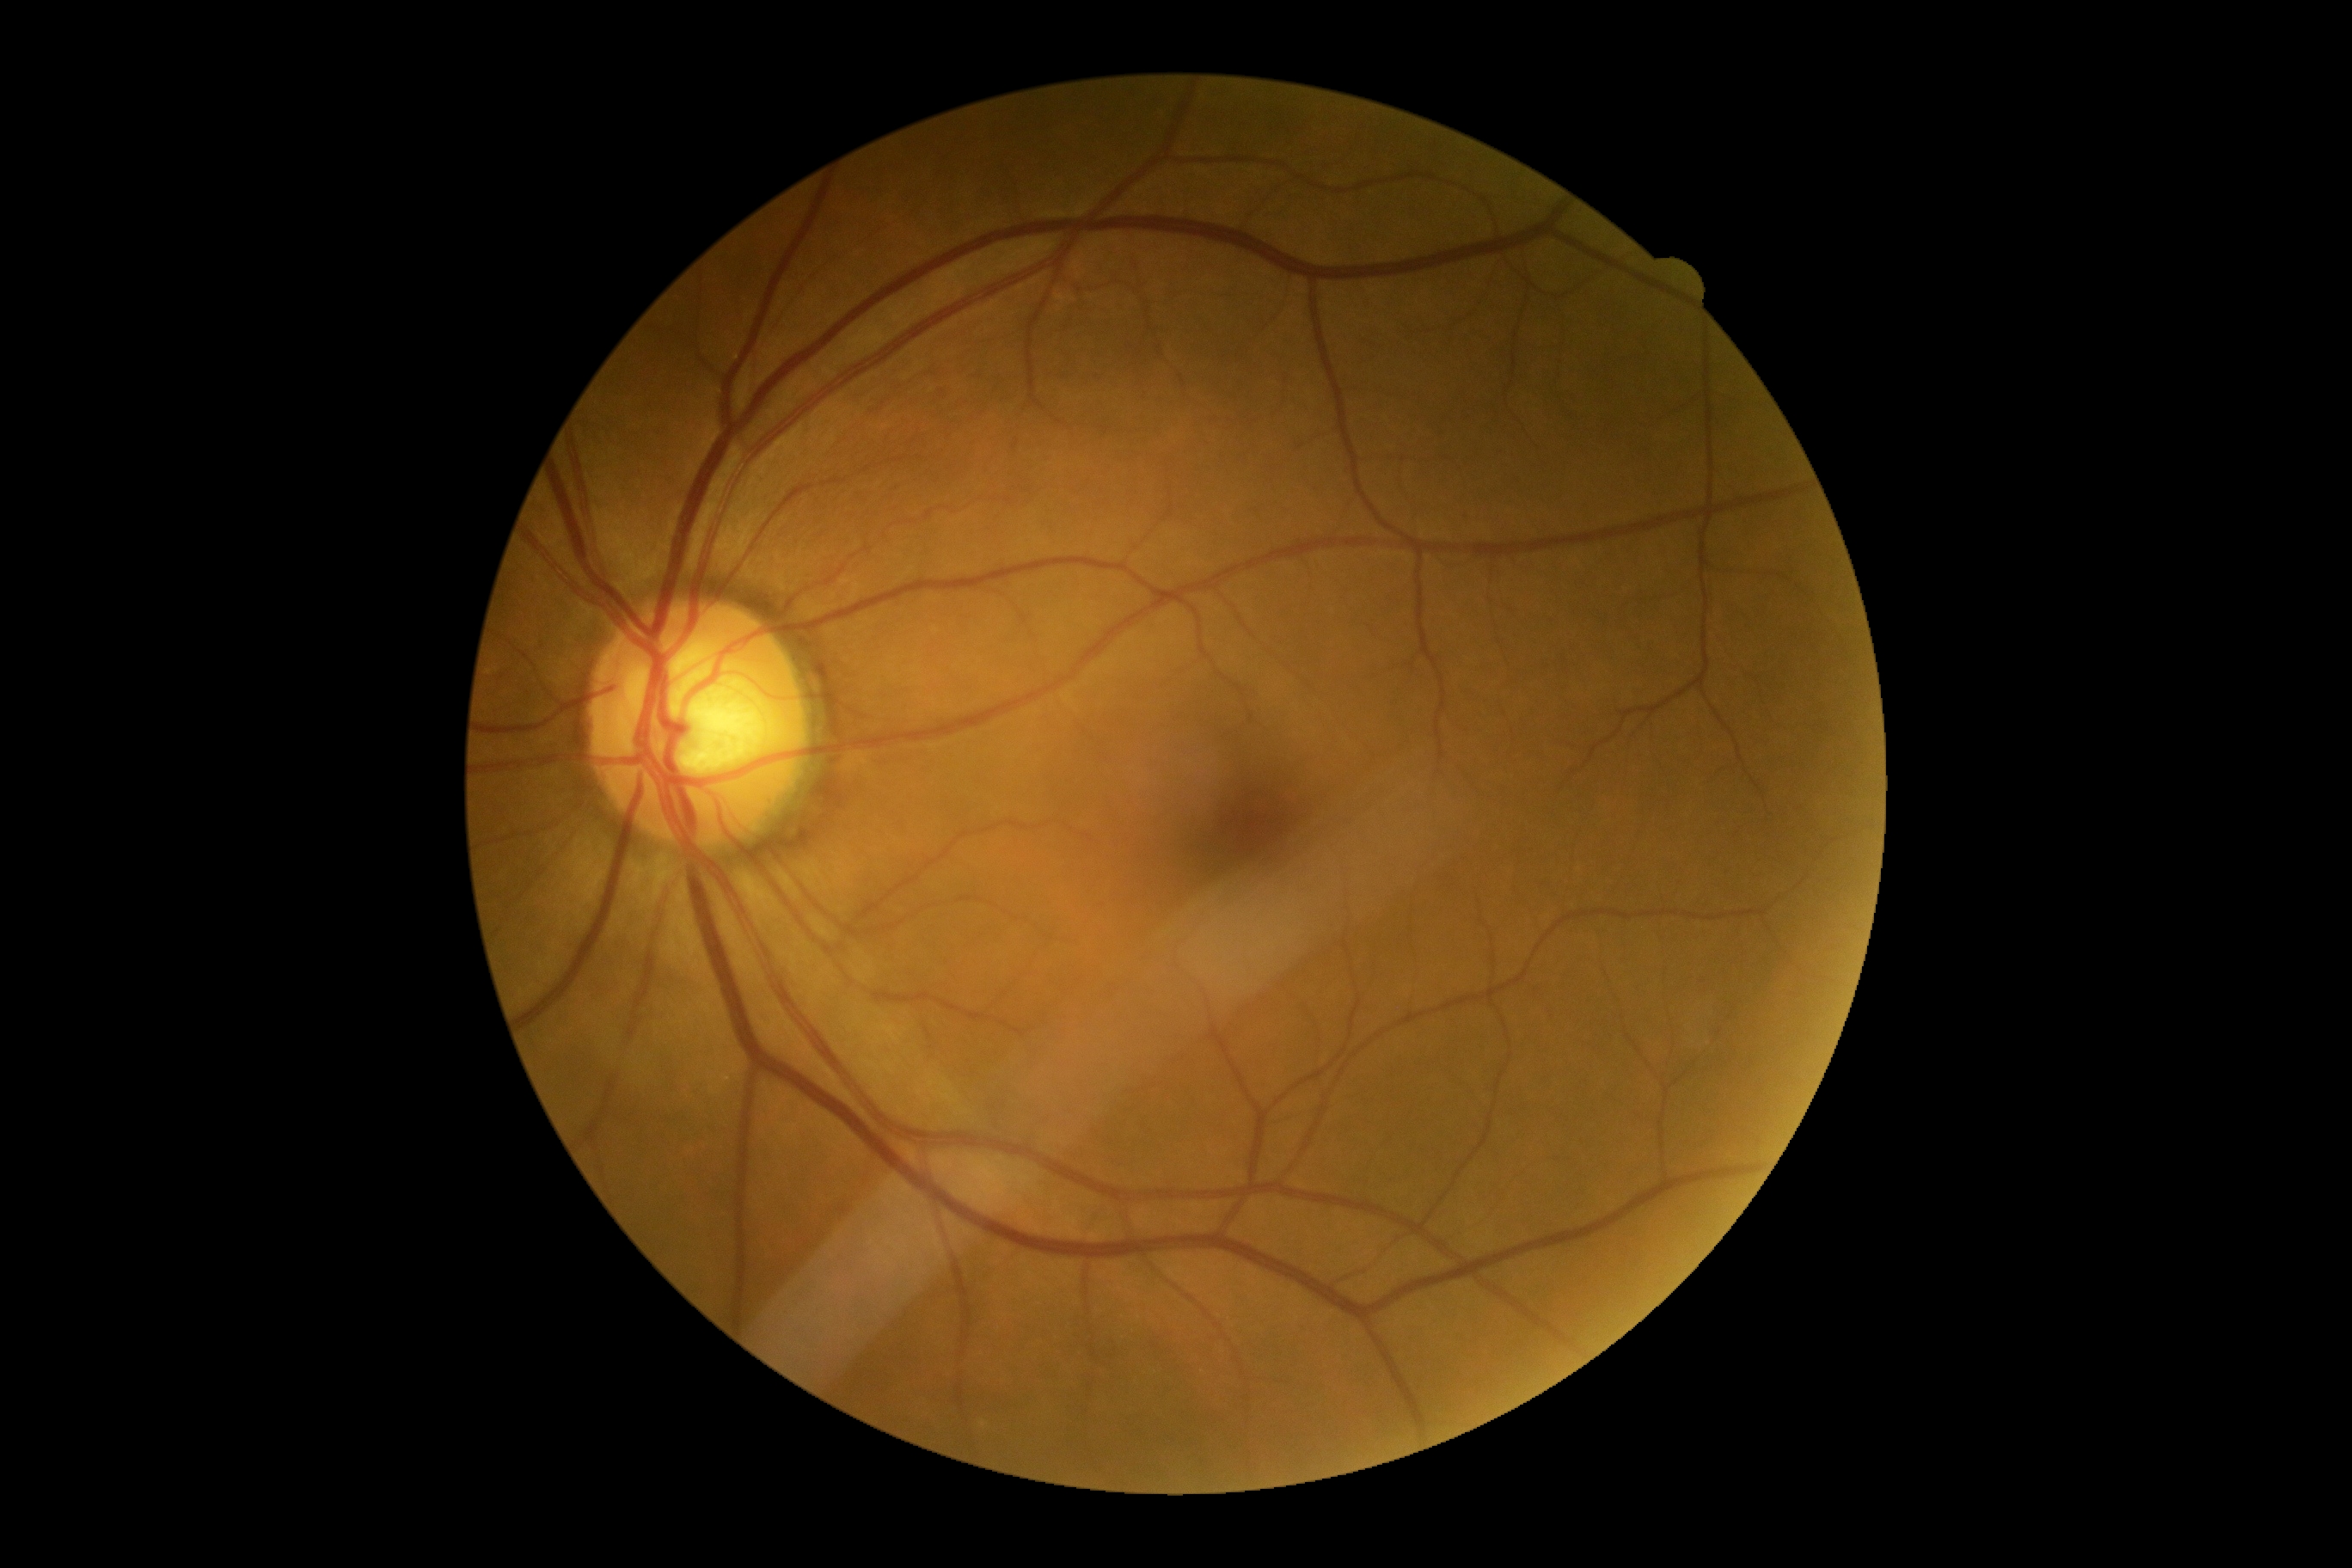
DR is 0/4.